Modified Davis grading: 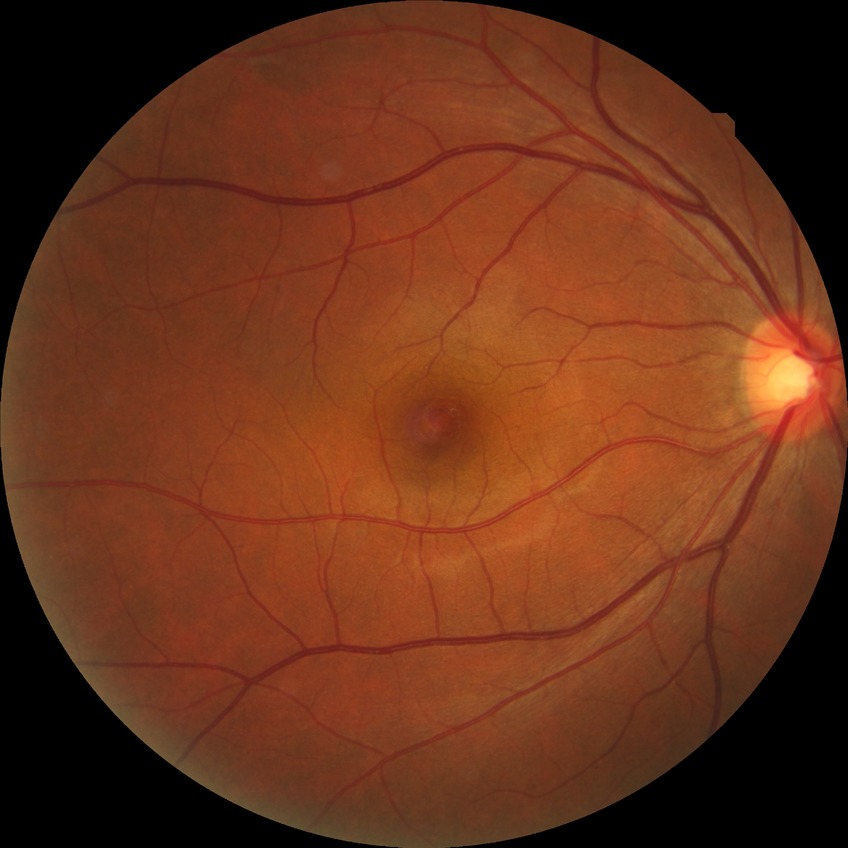
Diabetic retinopathy stage: no diabetic retinopathy.